Pediatric retinal photograph (wide-field) · image size 1240x1240: 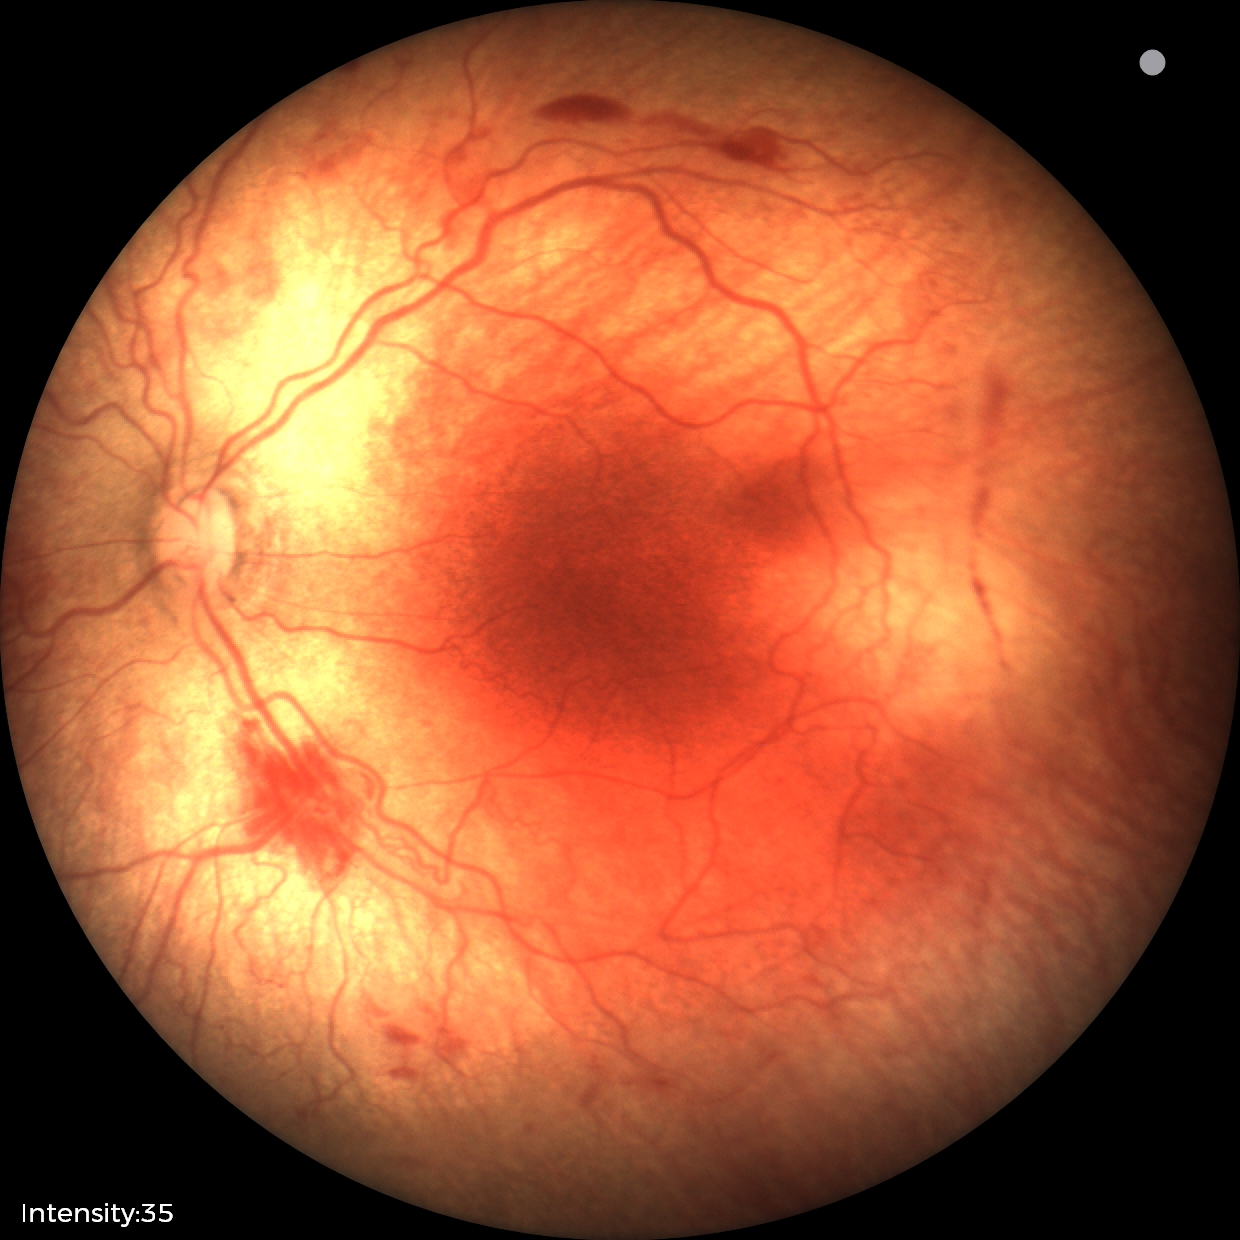 Plus disease was diagnosed.
Examination diagnosed as retinopathy of prematurity stage 2.